RetCam wide-field infant fundus image · image size 1440x1080
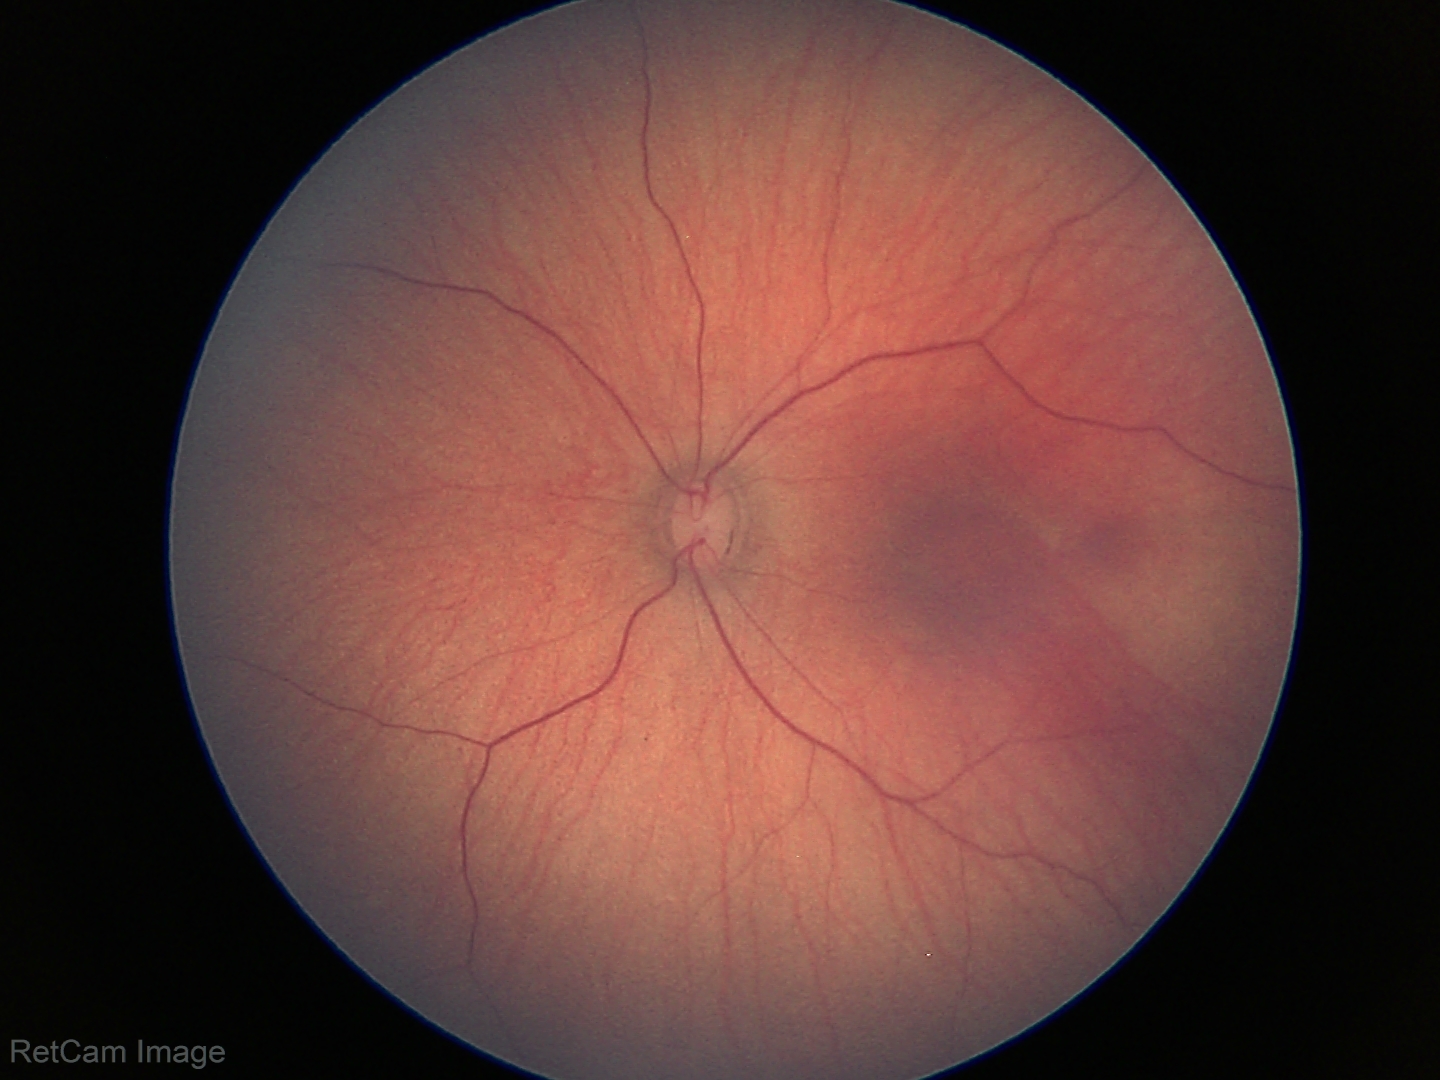
Assessment: normal fundus examination.